45° FOV, color fundus image: 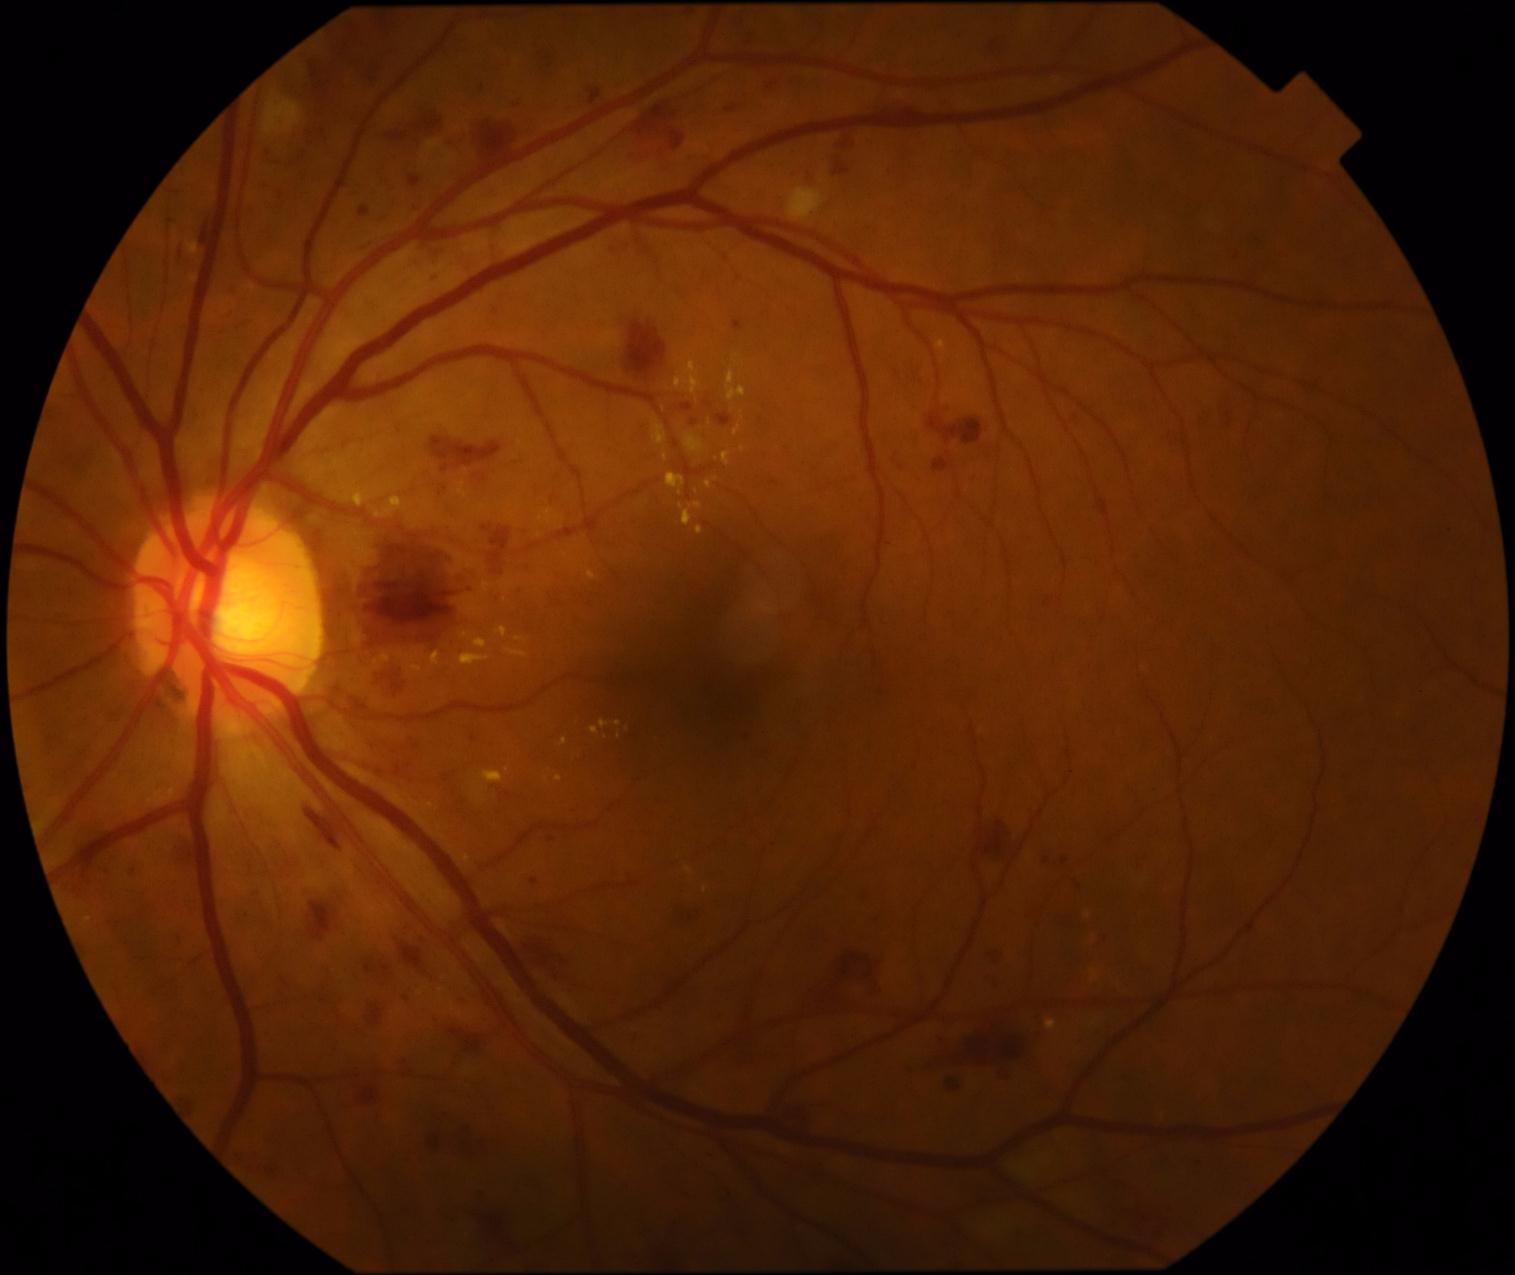
• diabetic retinopathy (DR): grade 3 (severe NPDR) — more than 20 intraretinal hemorrhages in each of 4 quadrants, definite venous beading in 2 or more quadrants, or prominent intraretinal microvascular abnormalities in 1 or more quadrants, with no signs of proliferative retinopathy